FOV: 45 degrees, CFP, 2048 by 1536 pixels: 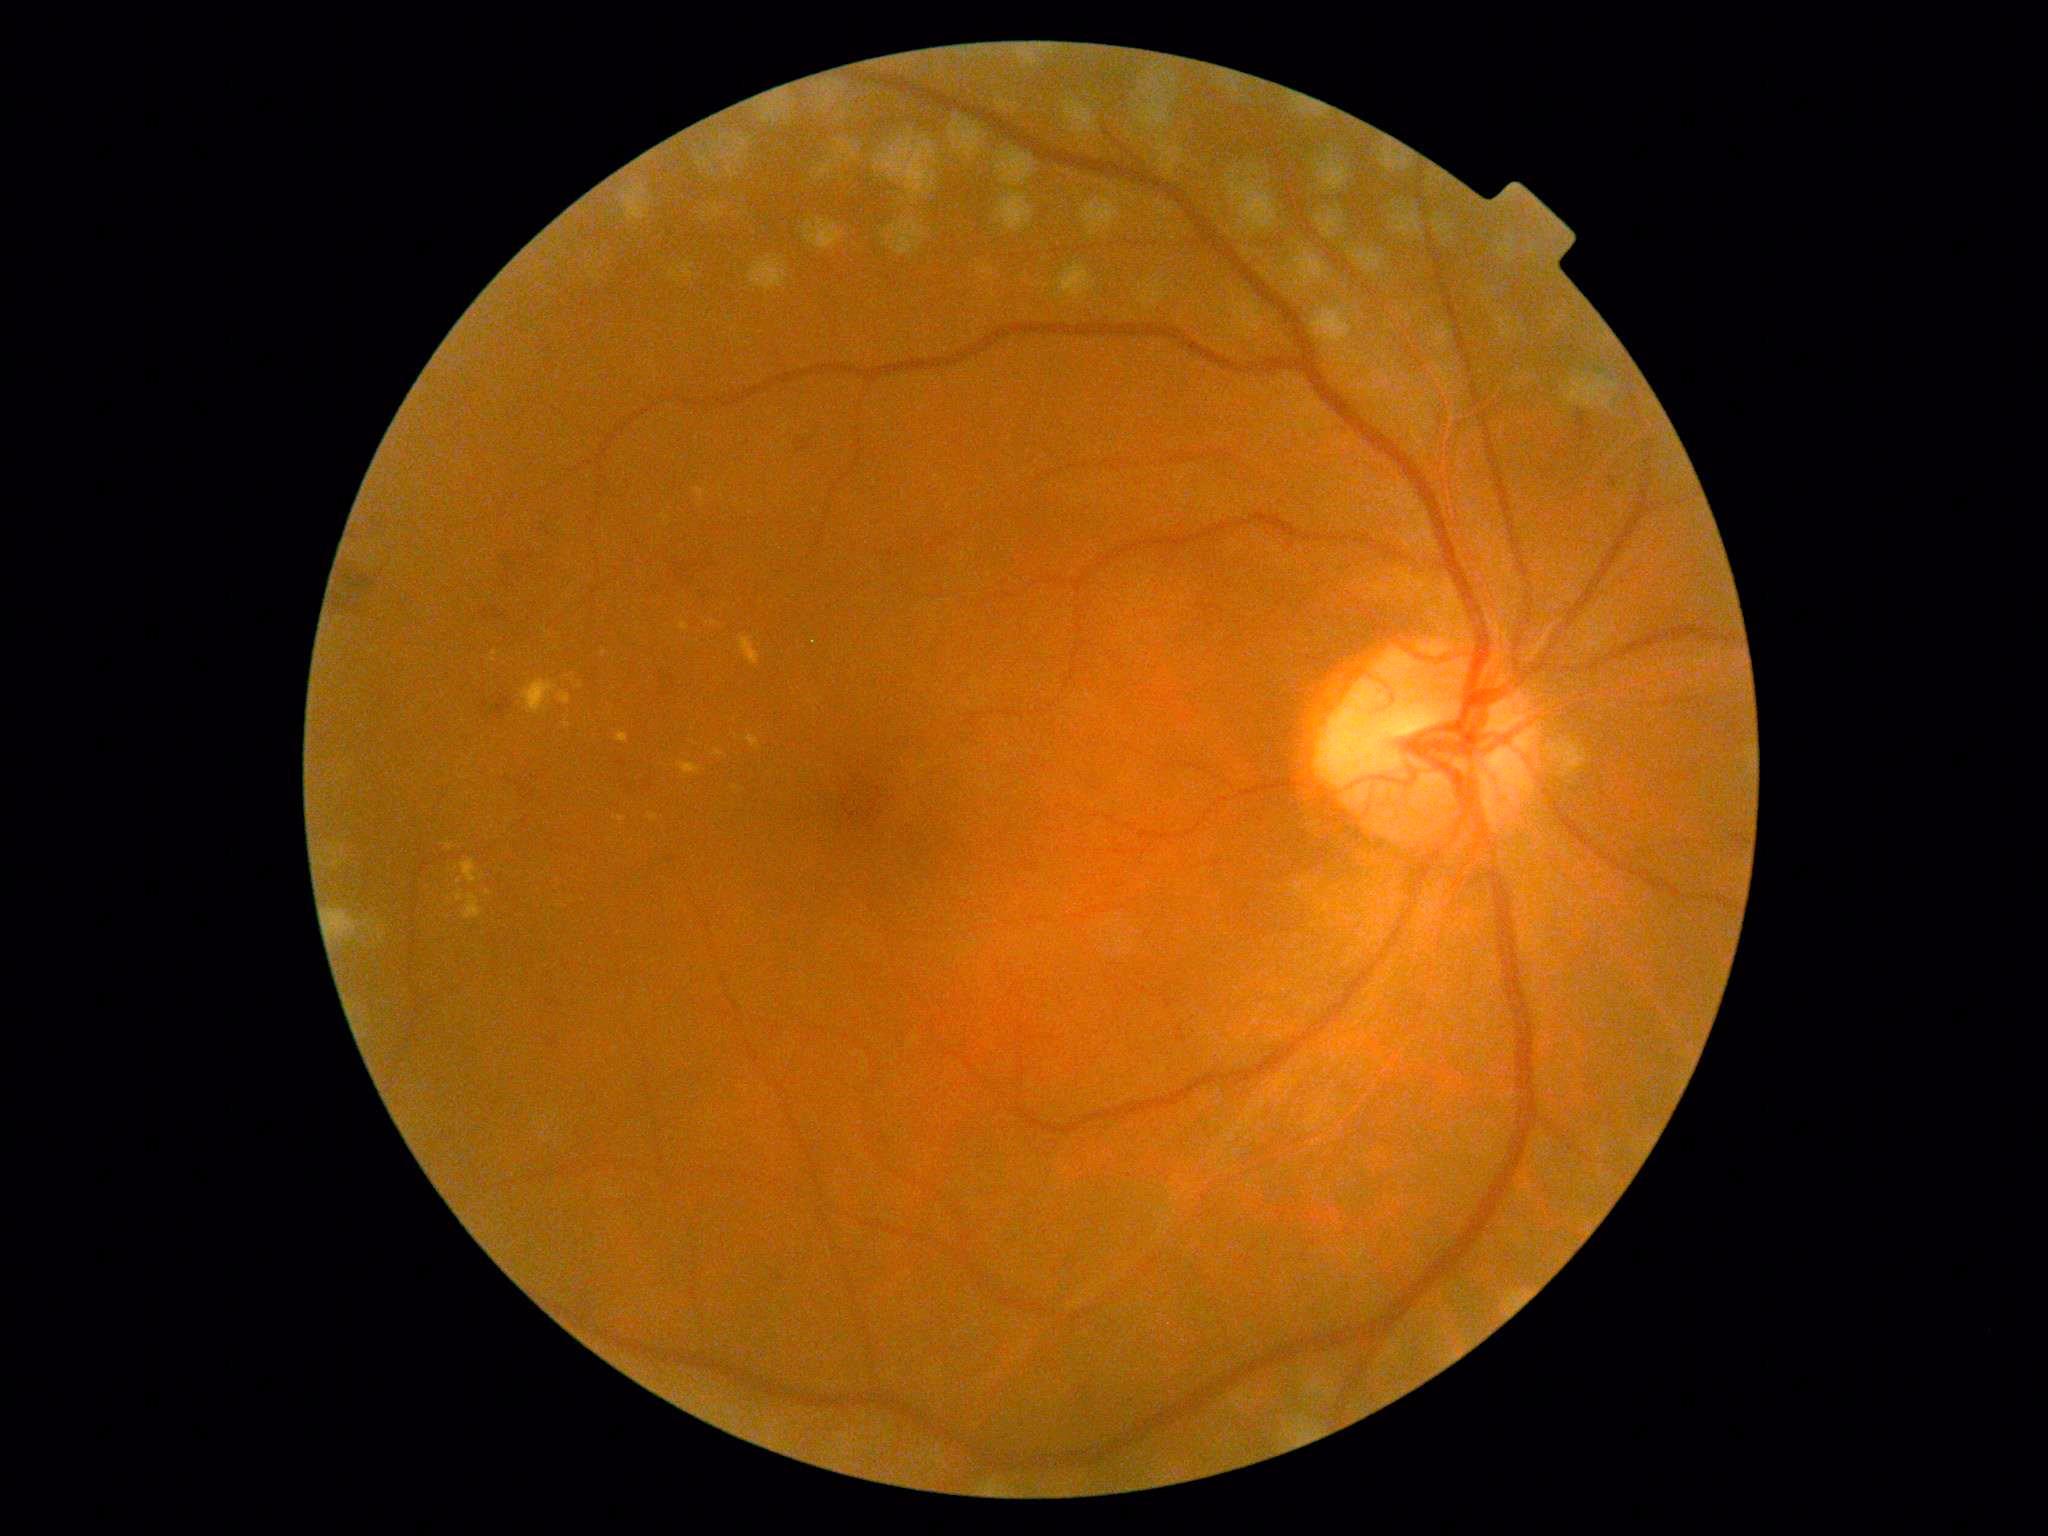 Diabetic retinopathy grade: 2. Disease class: non-proliferative diabetic retinopathy.